Autorefraction: +0.75 -0.75 × 109°; sex: M; corneal thickness 508 µm: 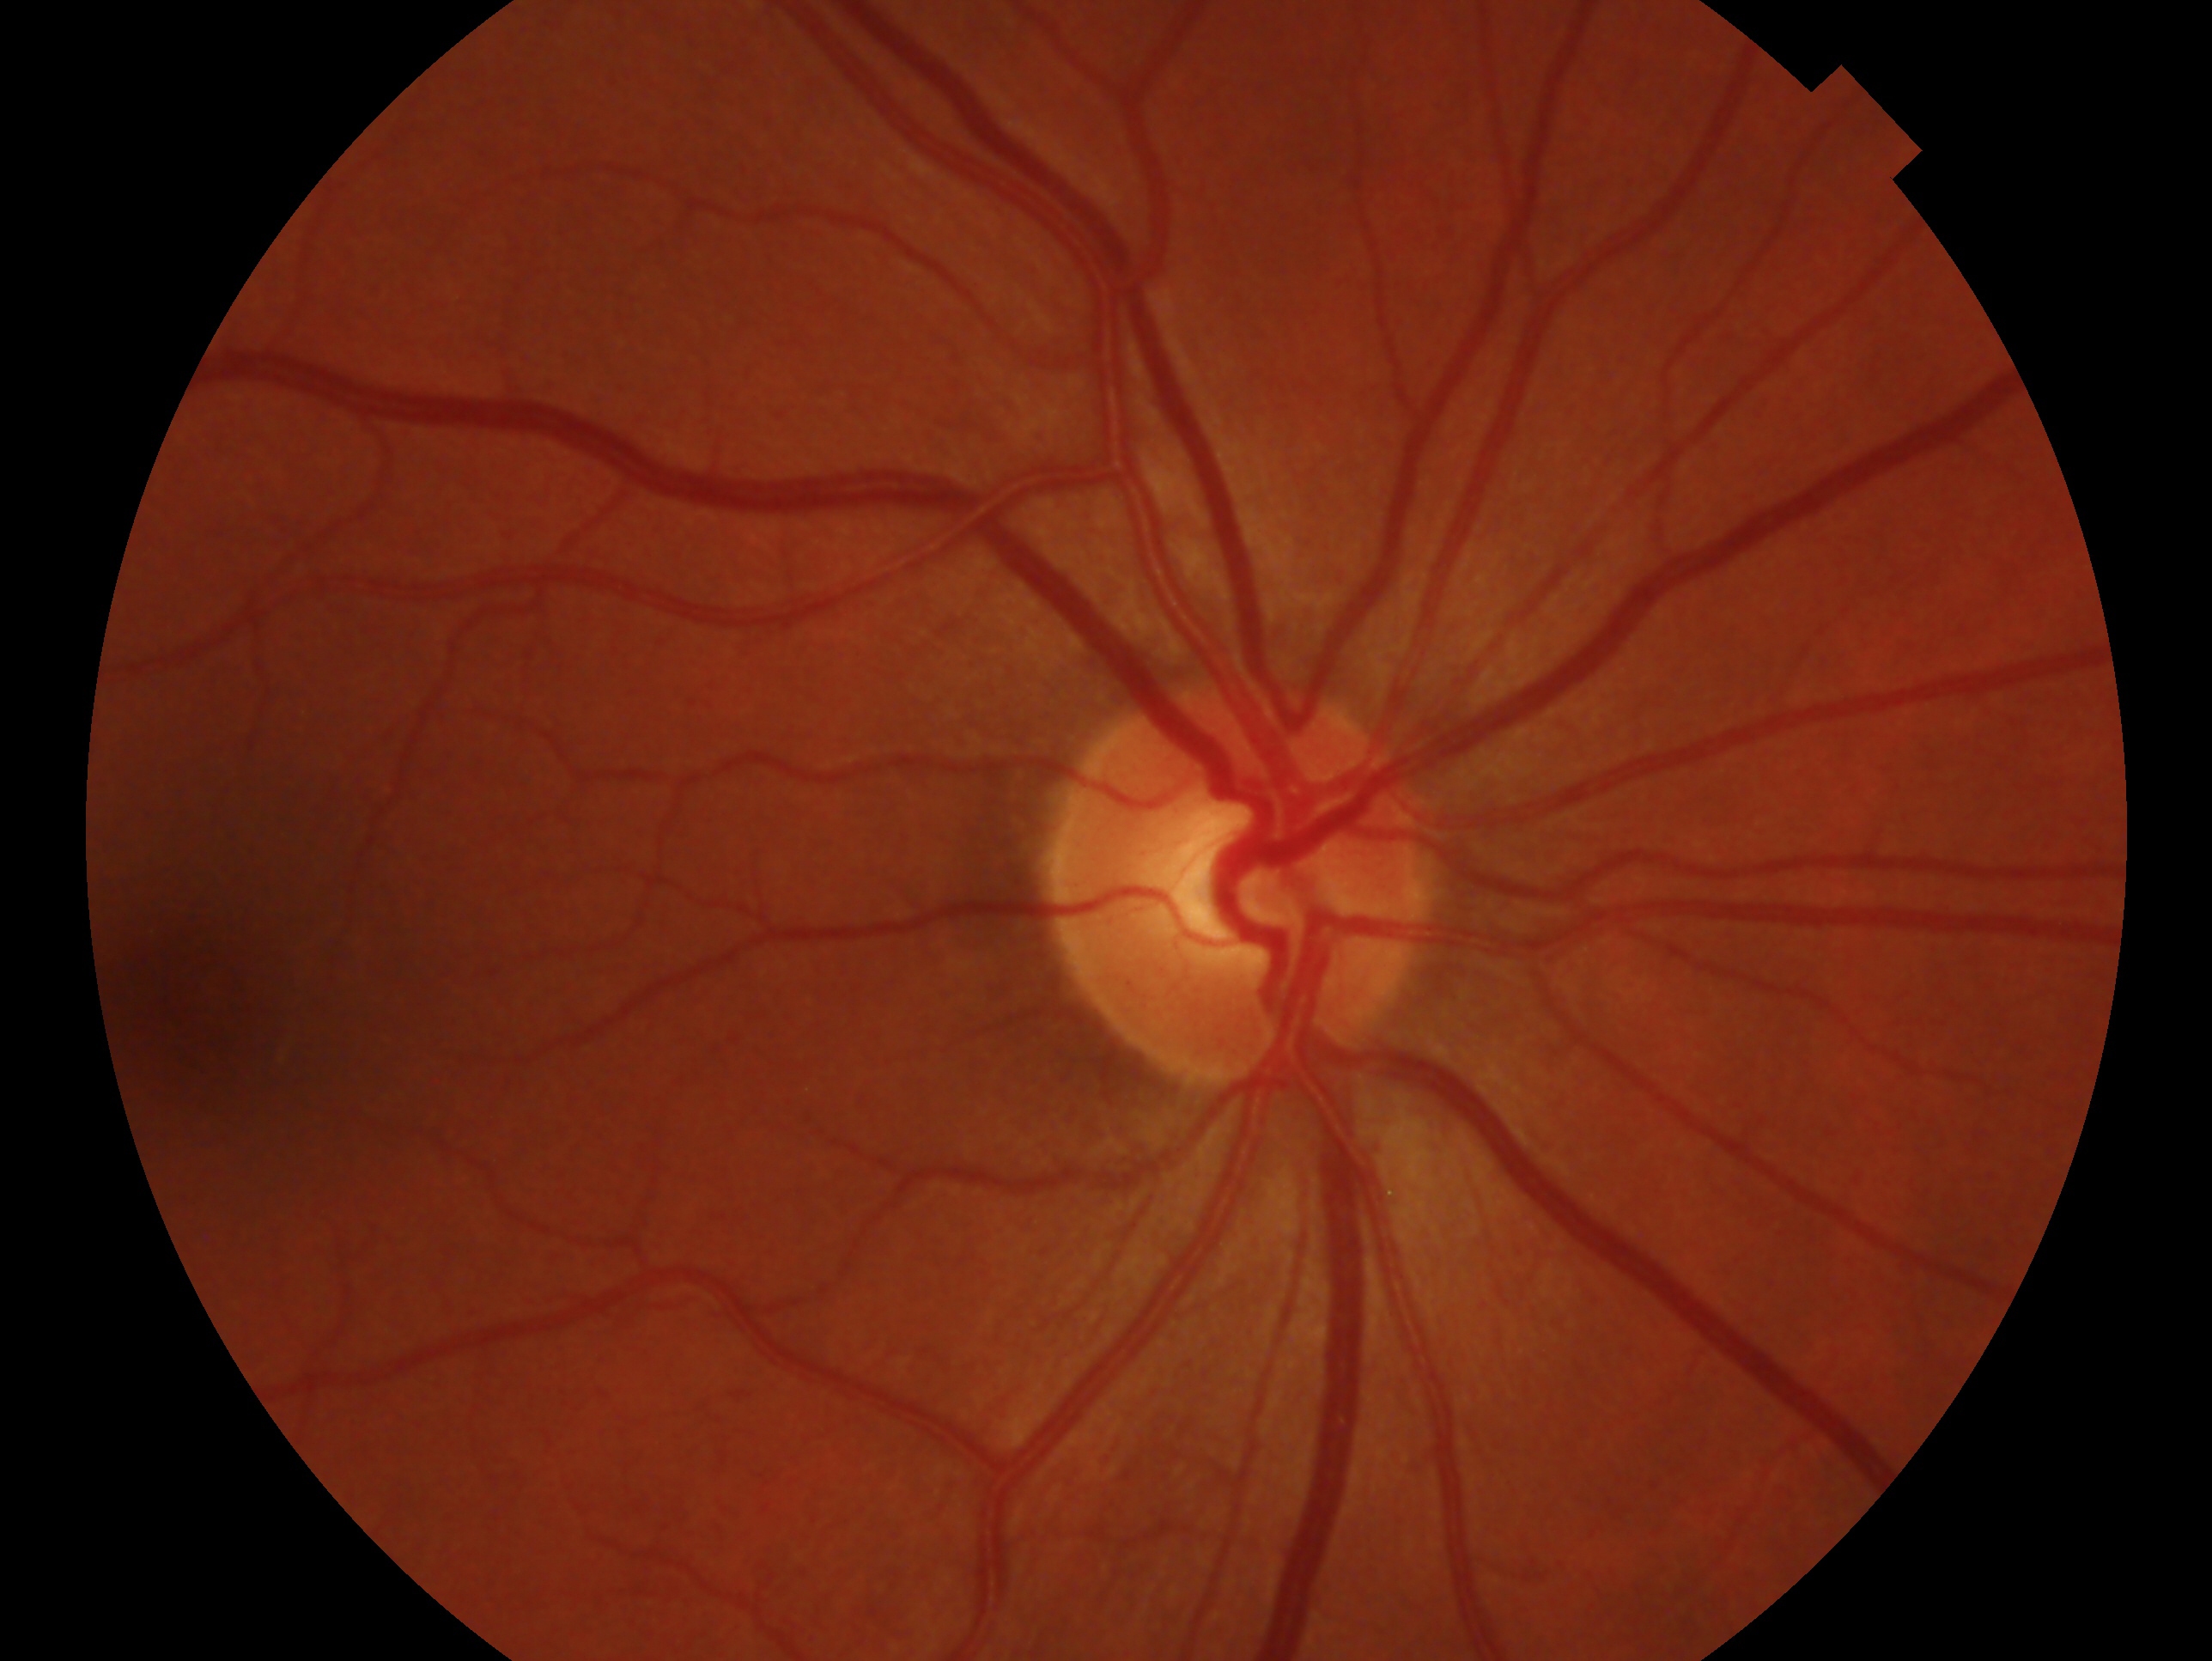 assessment: no glaucomatous findings — no clinical evidence of glaucoma in this eye, laterality: right eye.